Captured after pupil dilation: 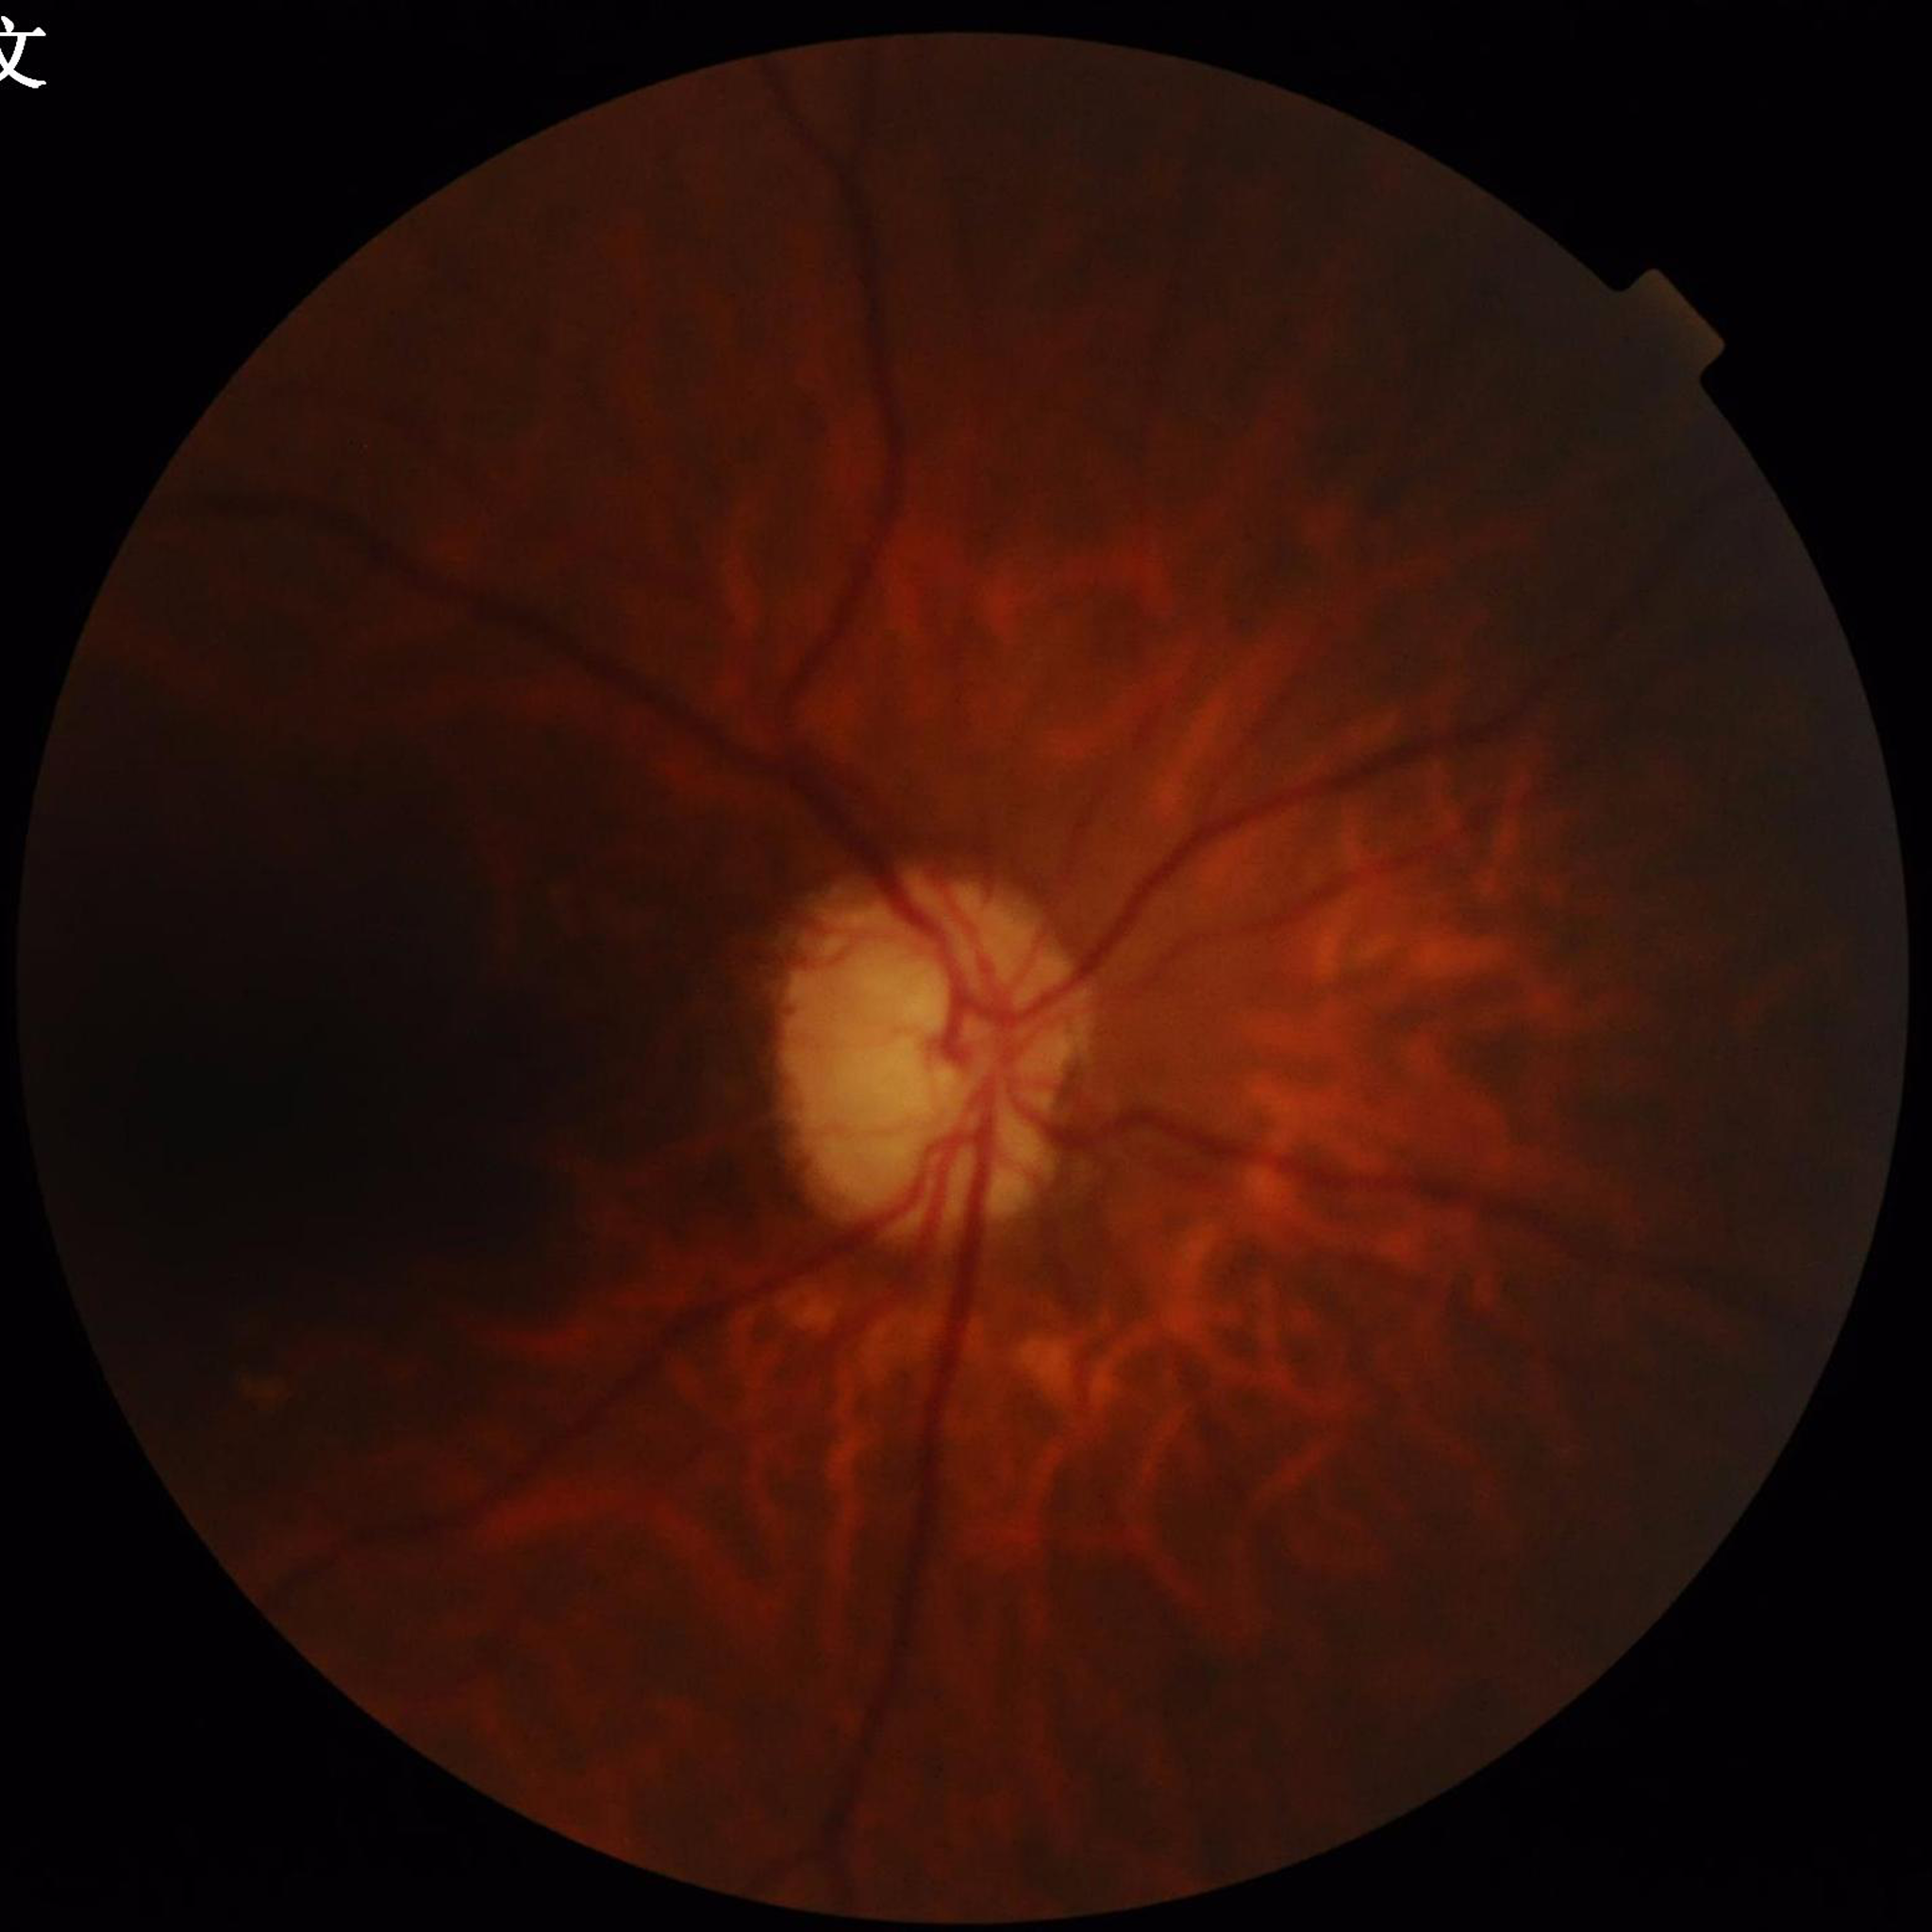

{
  "diagnosis": "glaucoma"
}